Color fundus image.
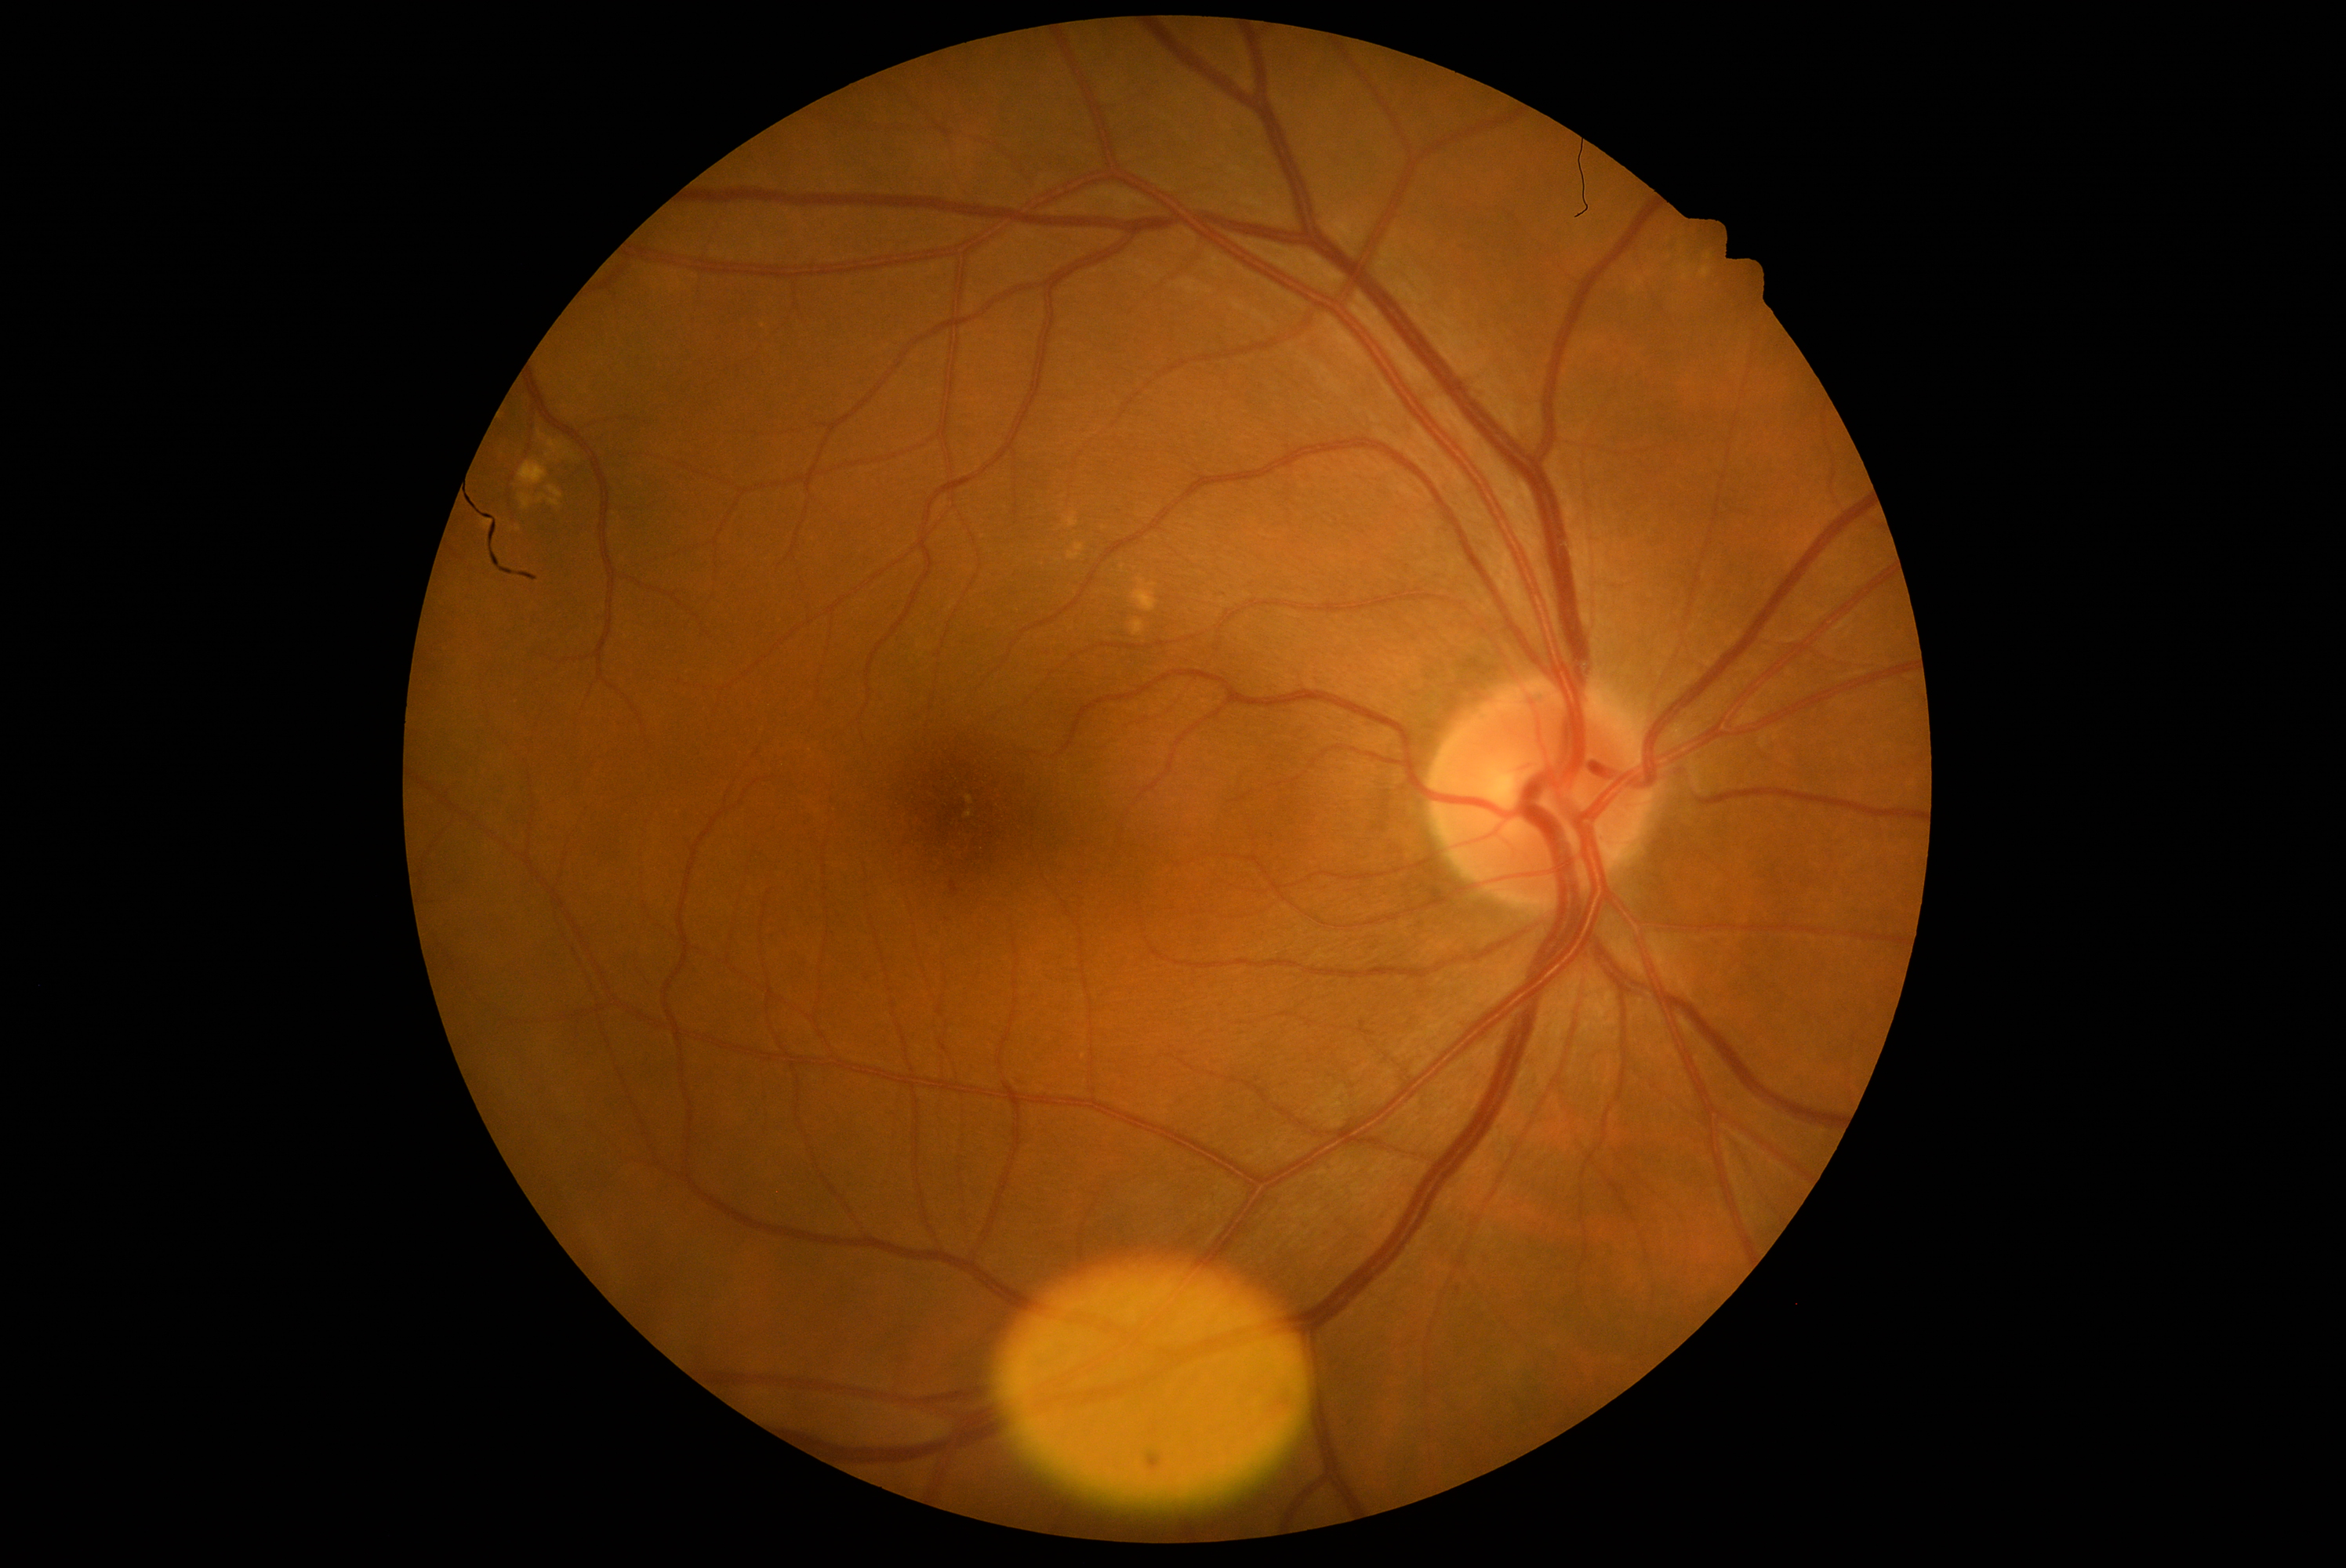
Annotations:
- DR severity: 1/4 — presence of microaneurysms only